Color fundus photograph. Central corneal thickness: 600 µm. Centered on the optic disc. Axial length: 23.87 mm. Patient age: 52 years. Image size 2212x1661
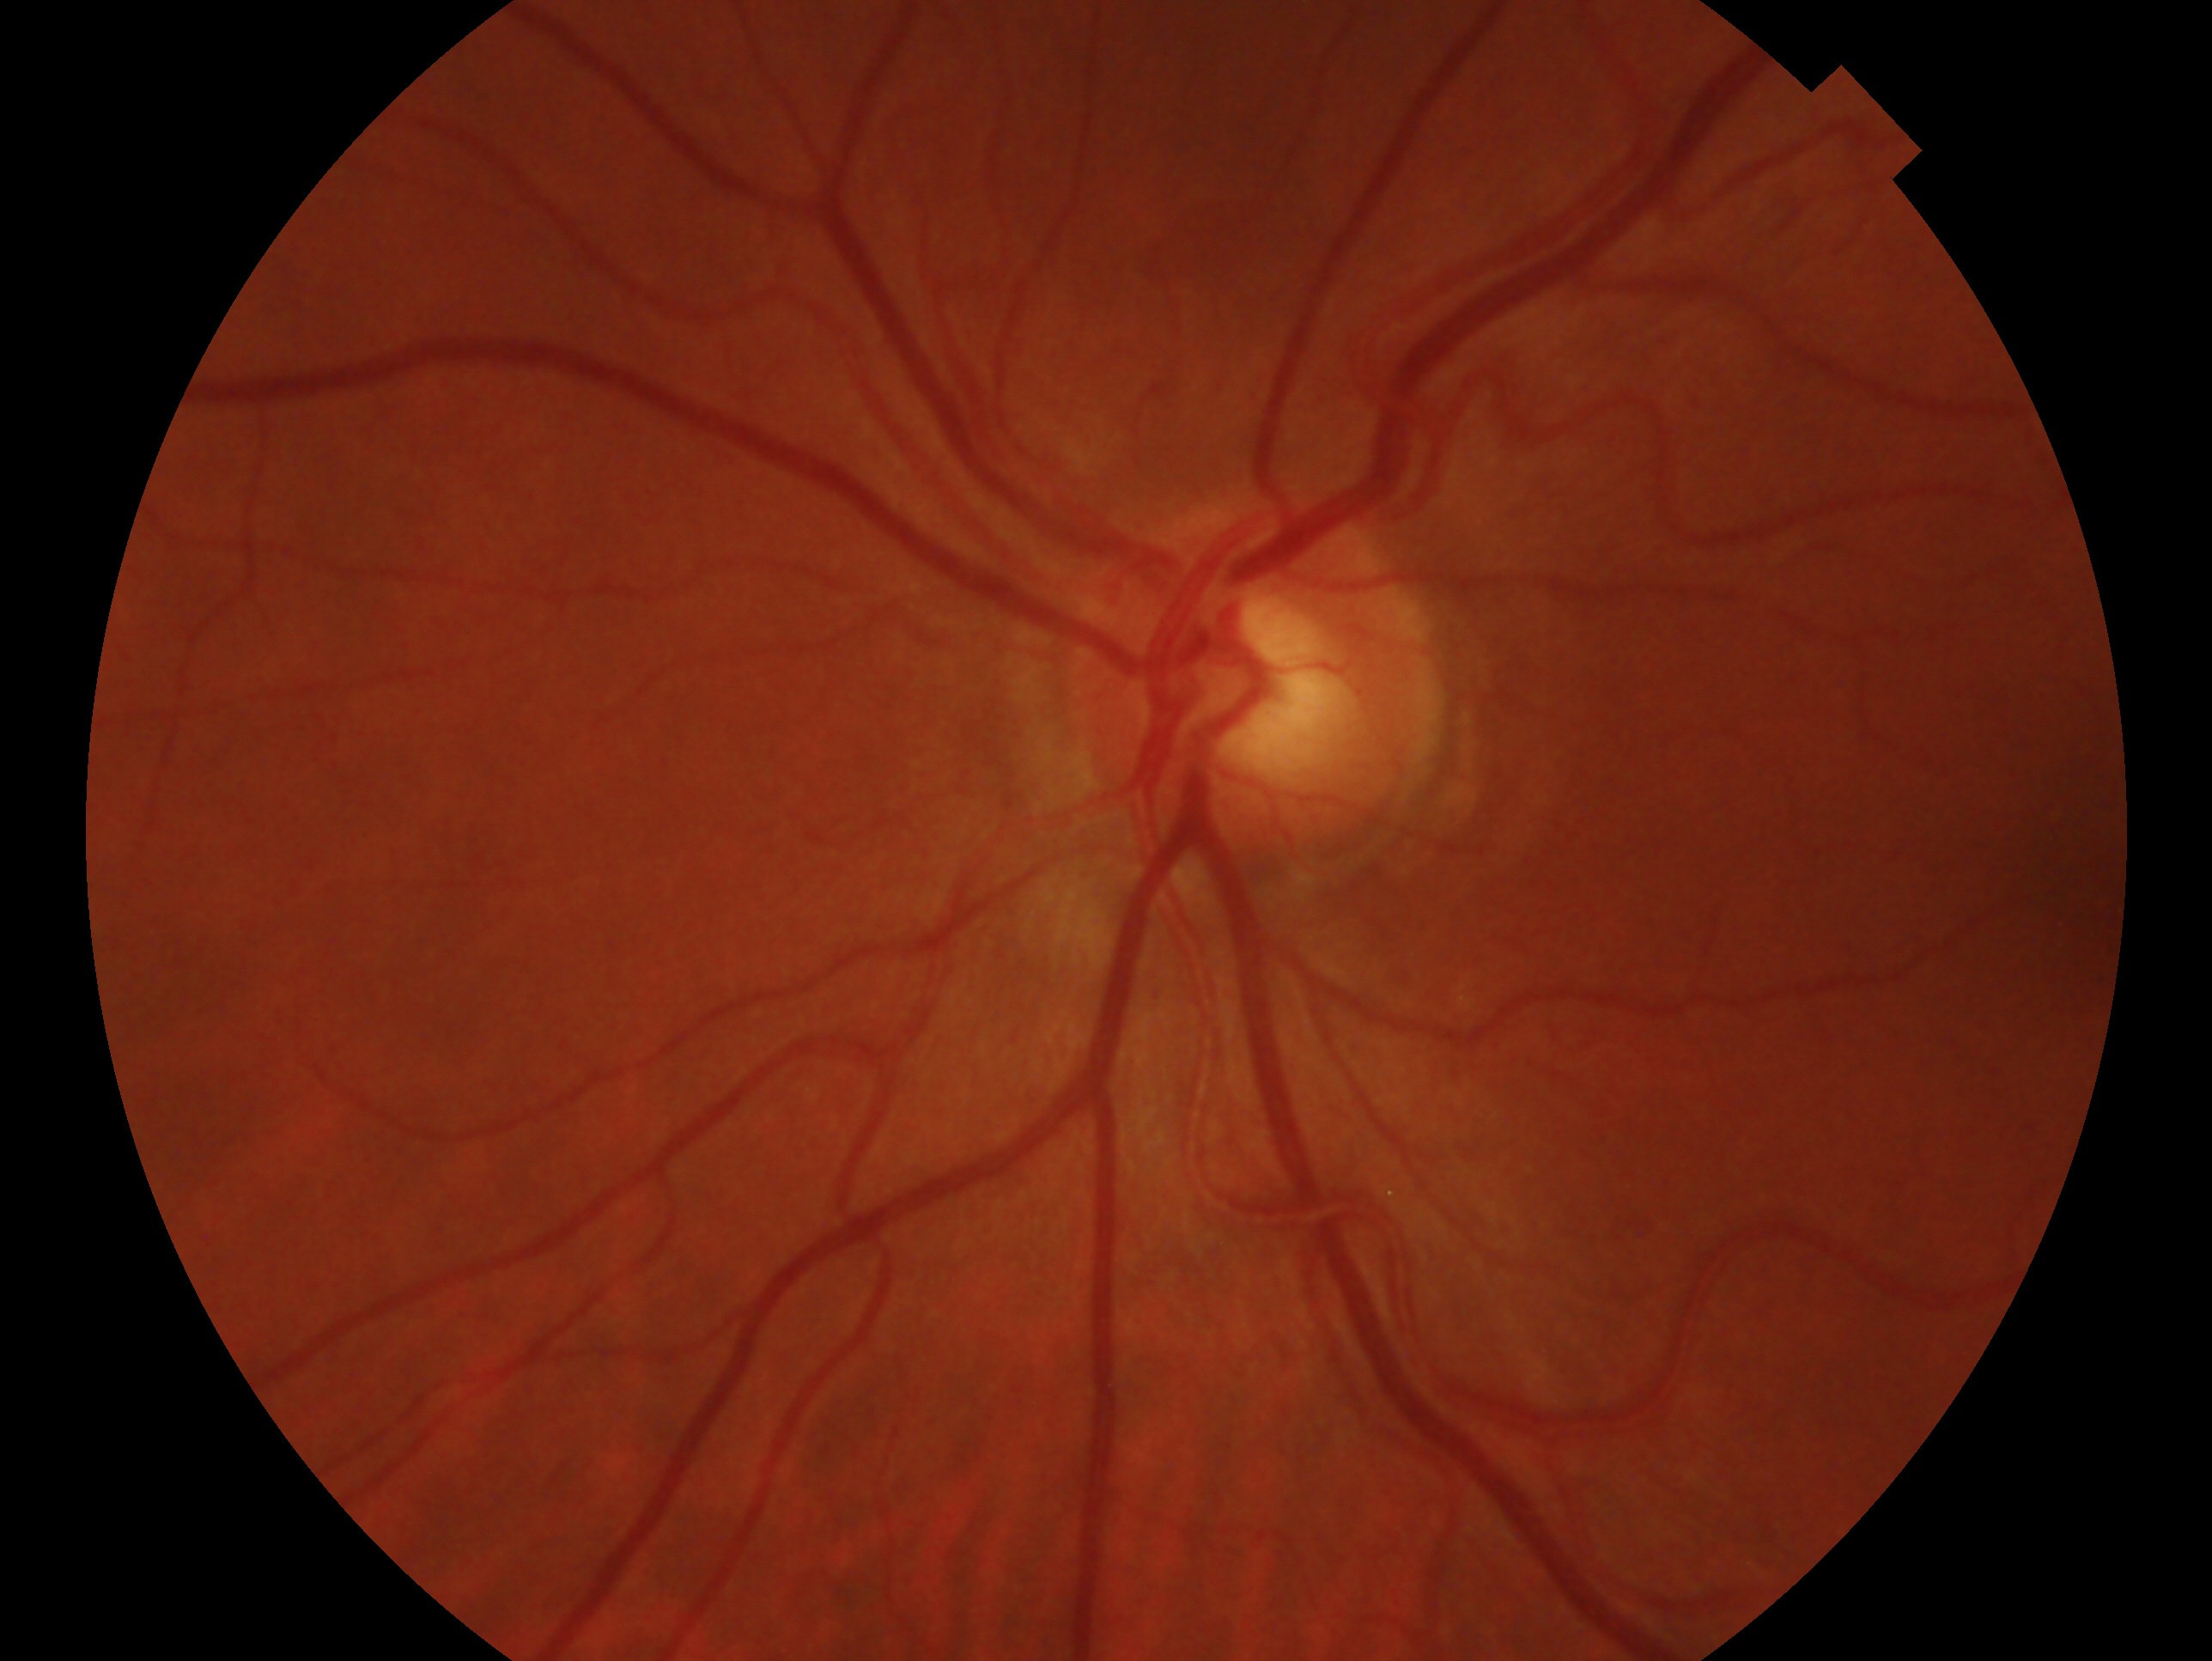

diagnosis: no glaucomatous findings | laterality: oculus sinister.